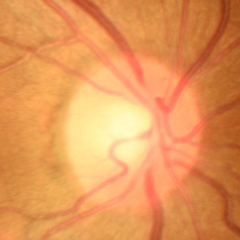
Demonstrates no evidence of glaucoma.